45-degree field of view; nonmydriatic fundus photograph:
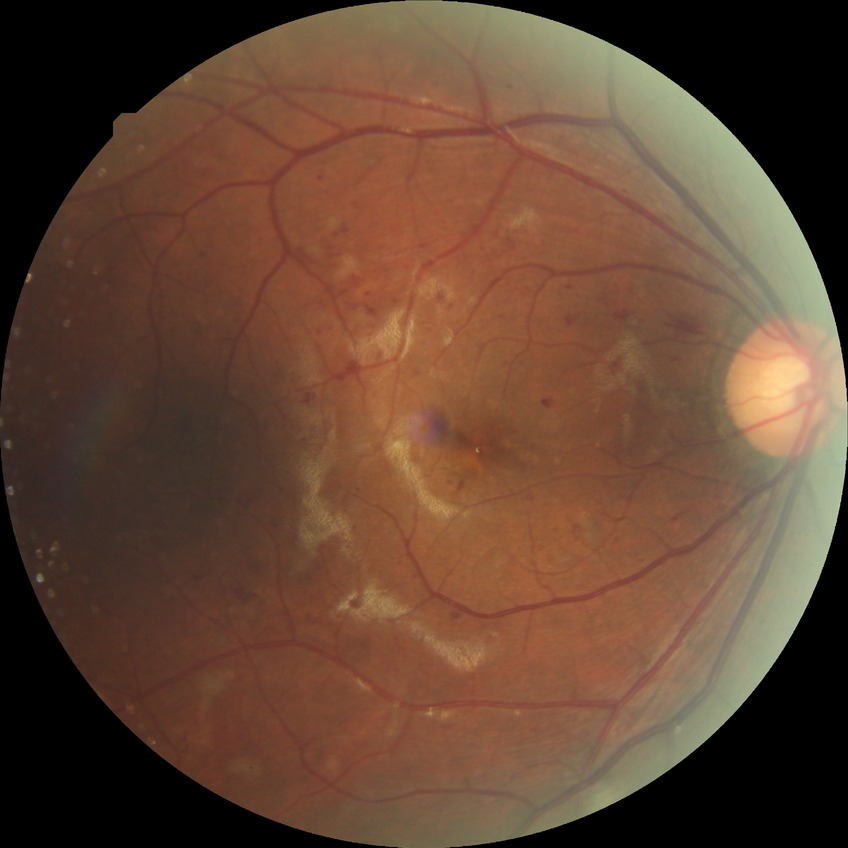

Diabetic retinopathy (DR) is pre-proliferative diabetic retinopathy (PPDR).